Image size 2352x1568: 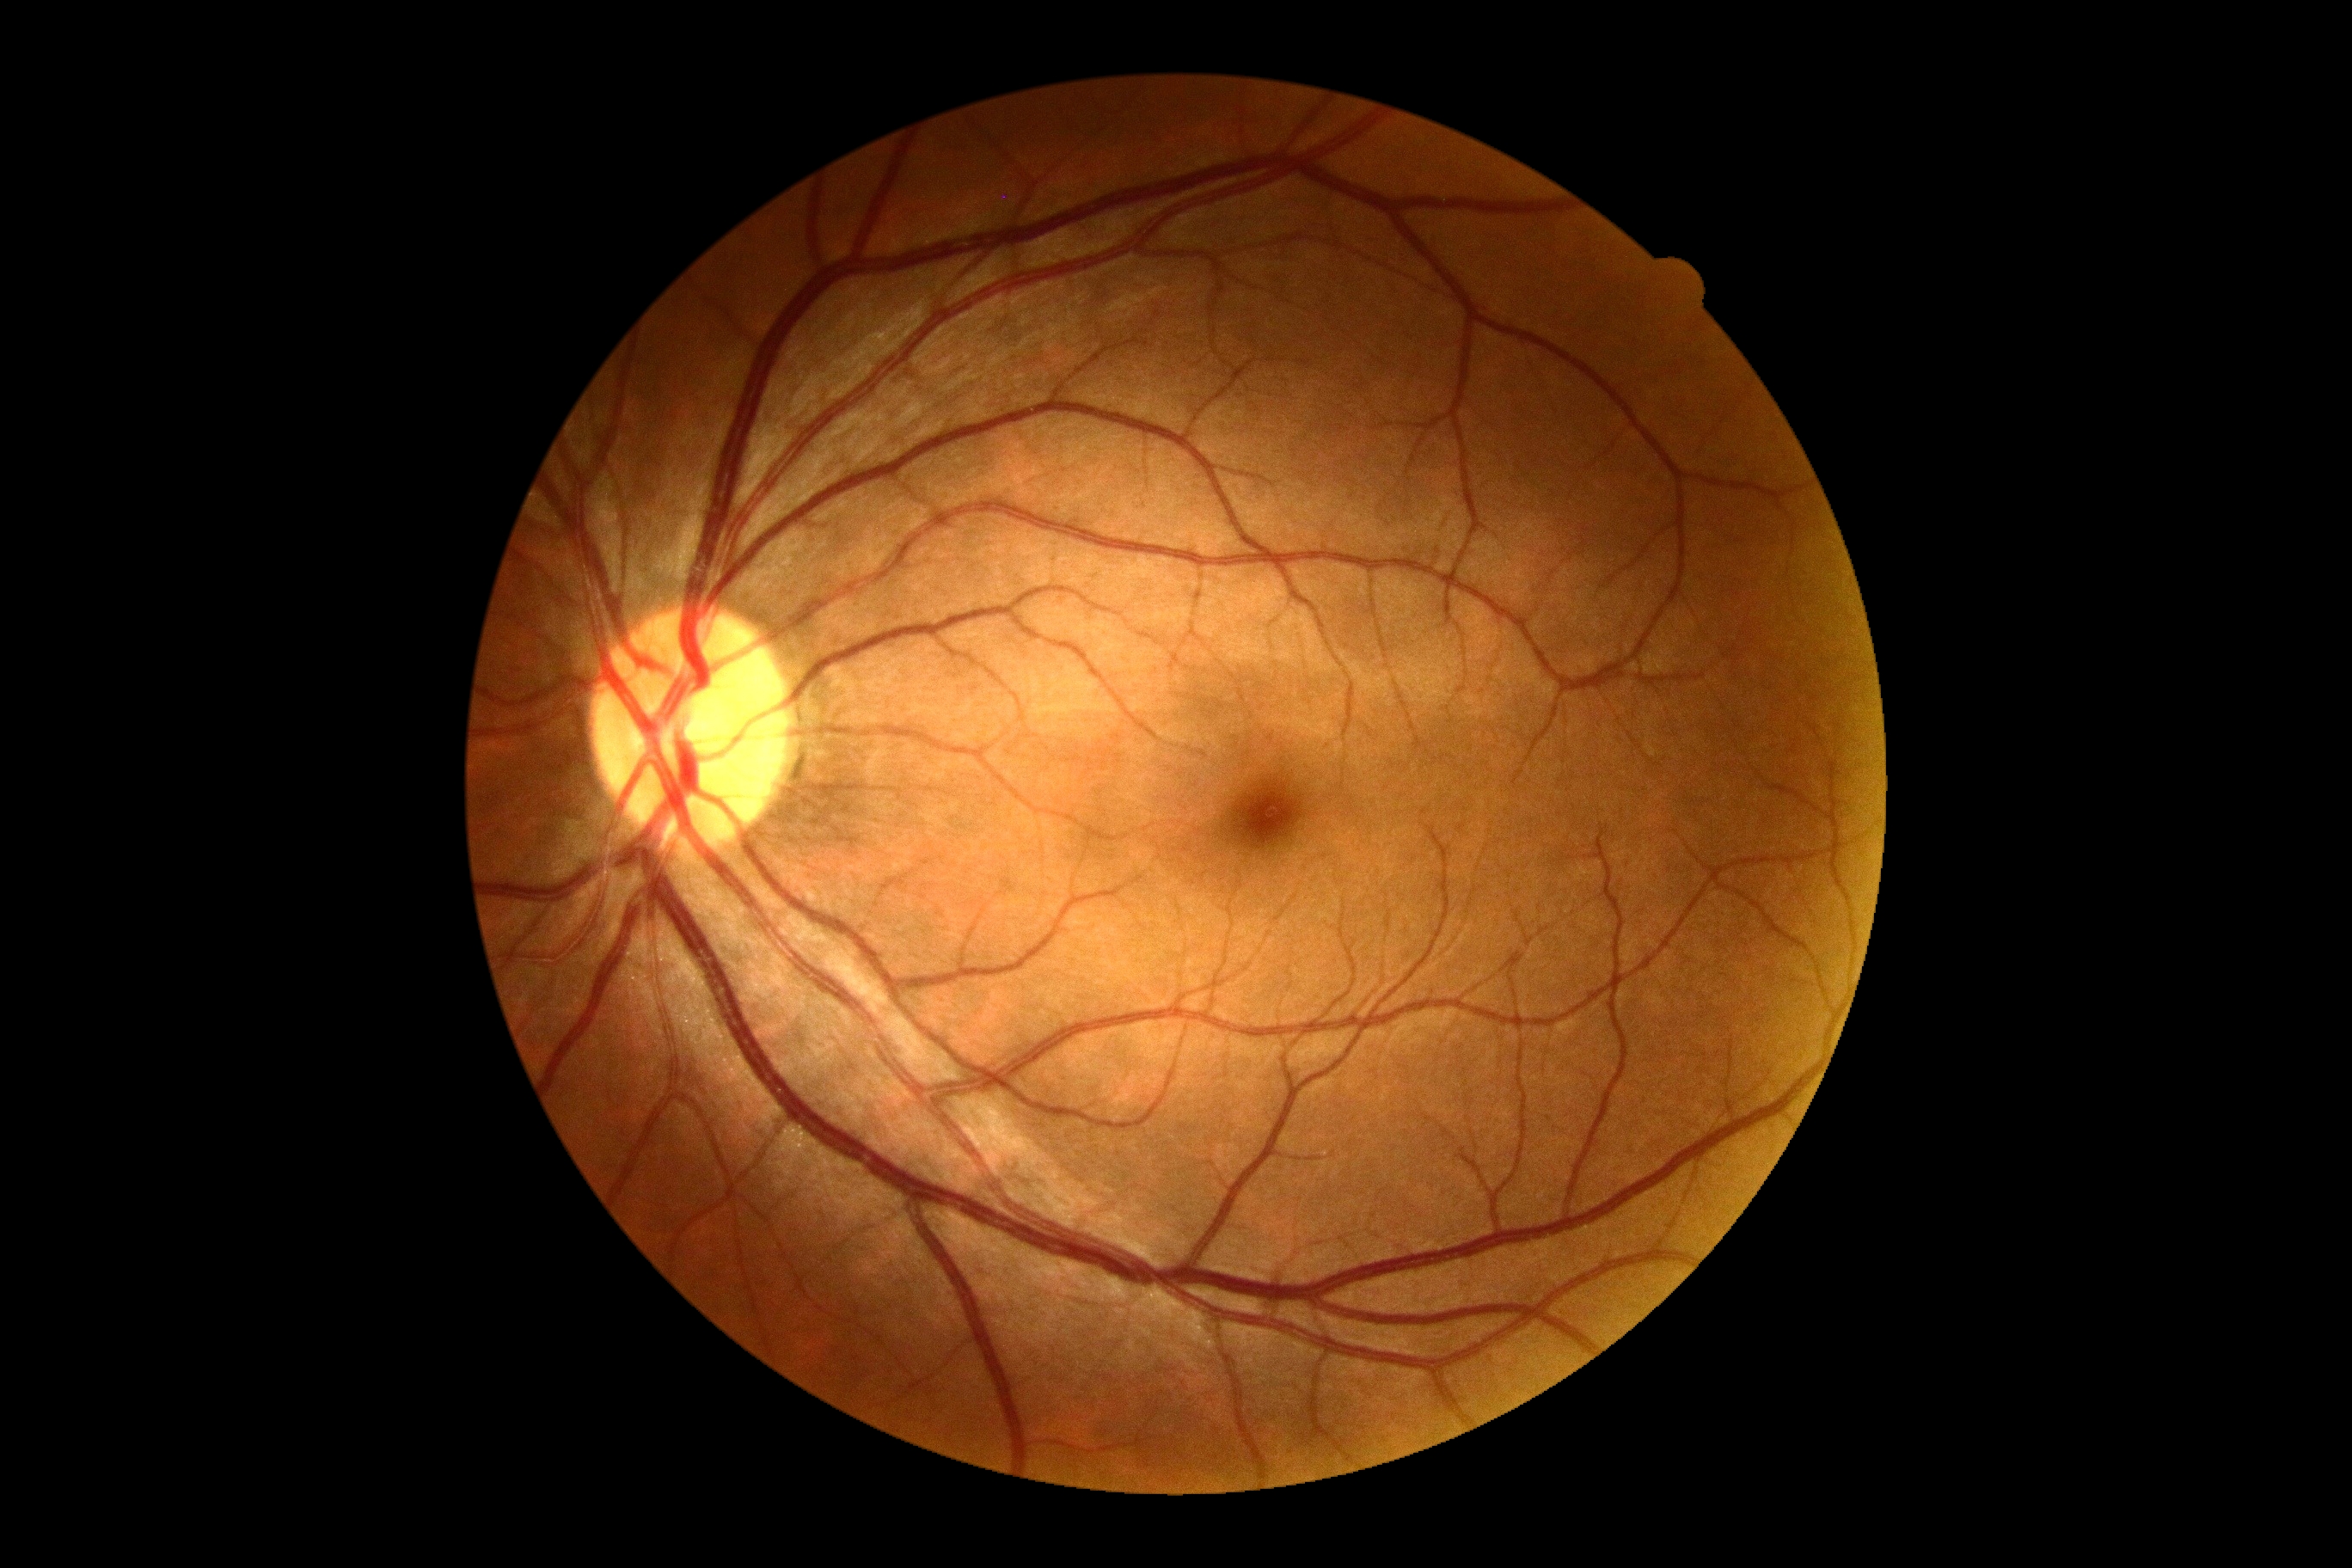 diabetic retinopathy: 0/4, DR impression: no signs of DR.